848 by 848 pixels. Modified Davis classification.
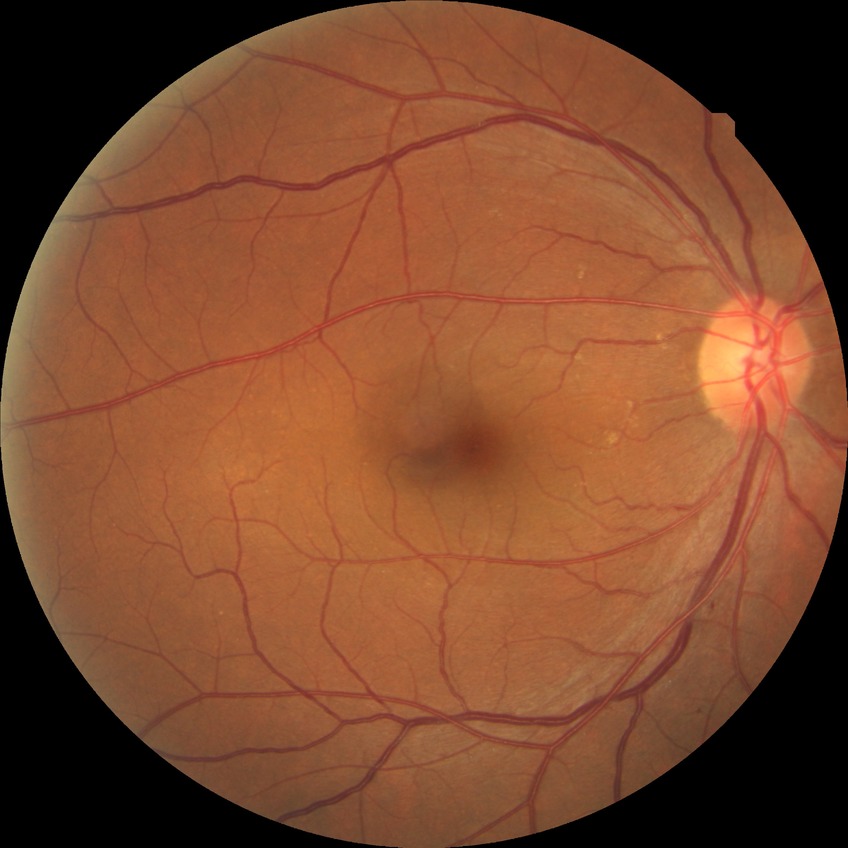

No DR findings.
DR grade is NDR.